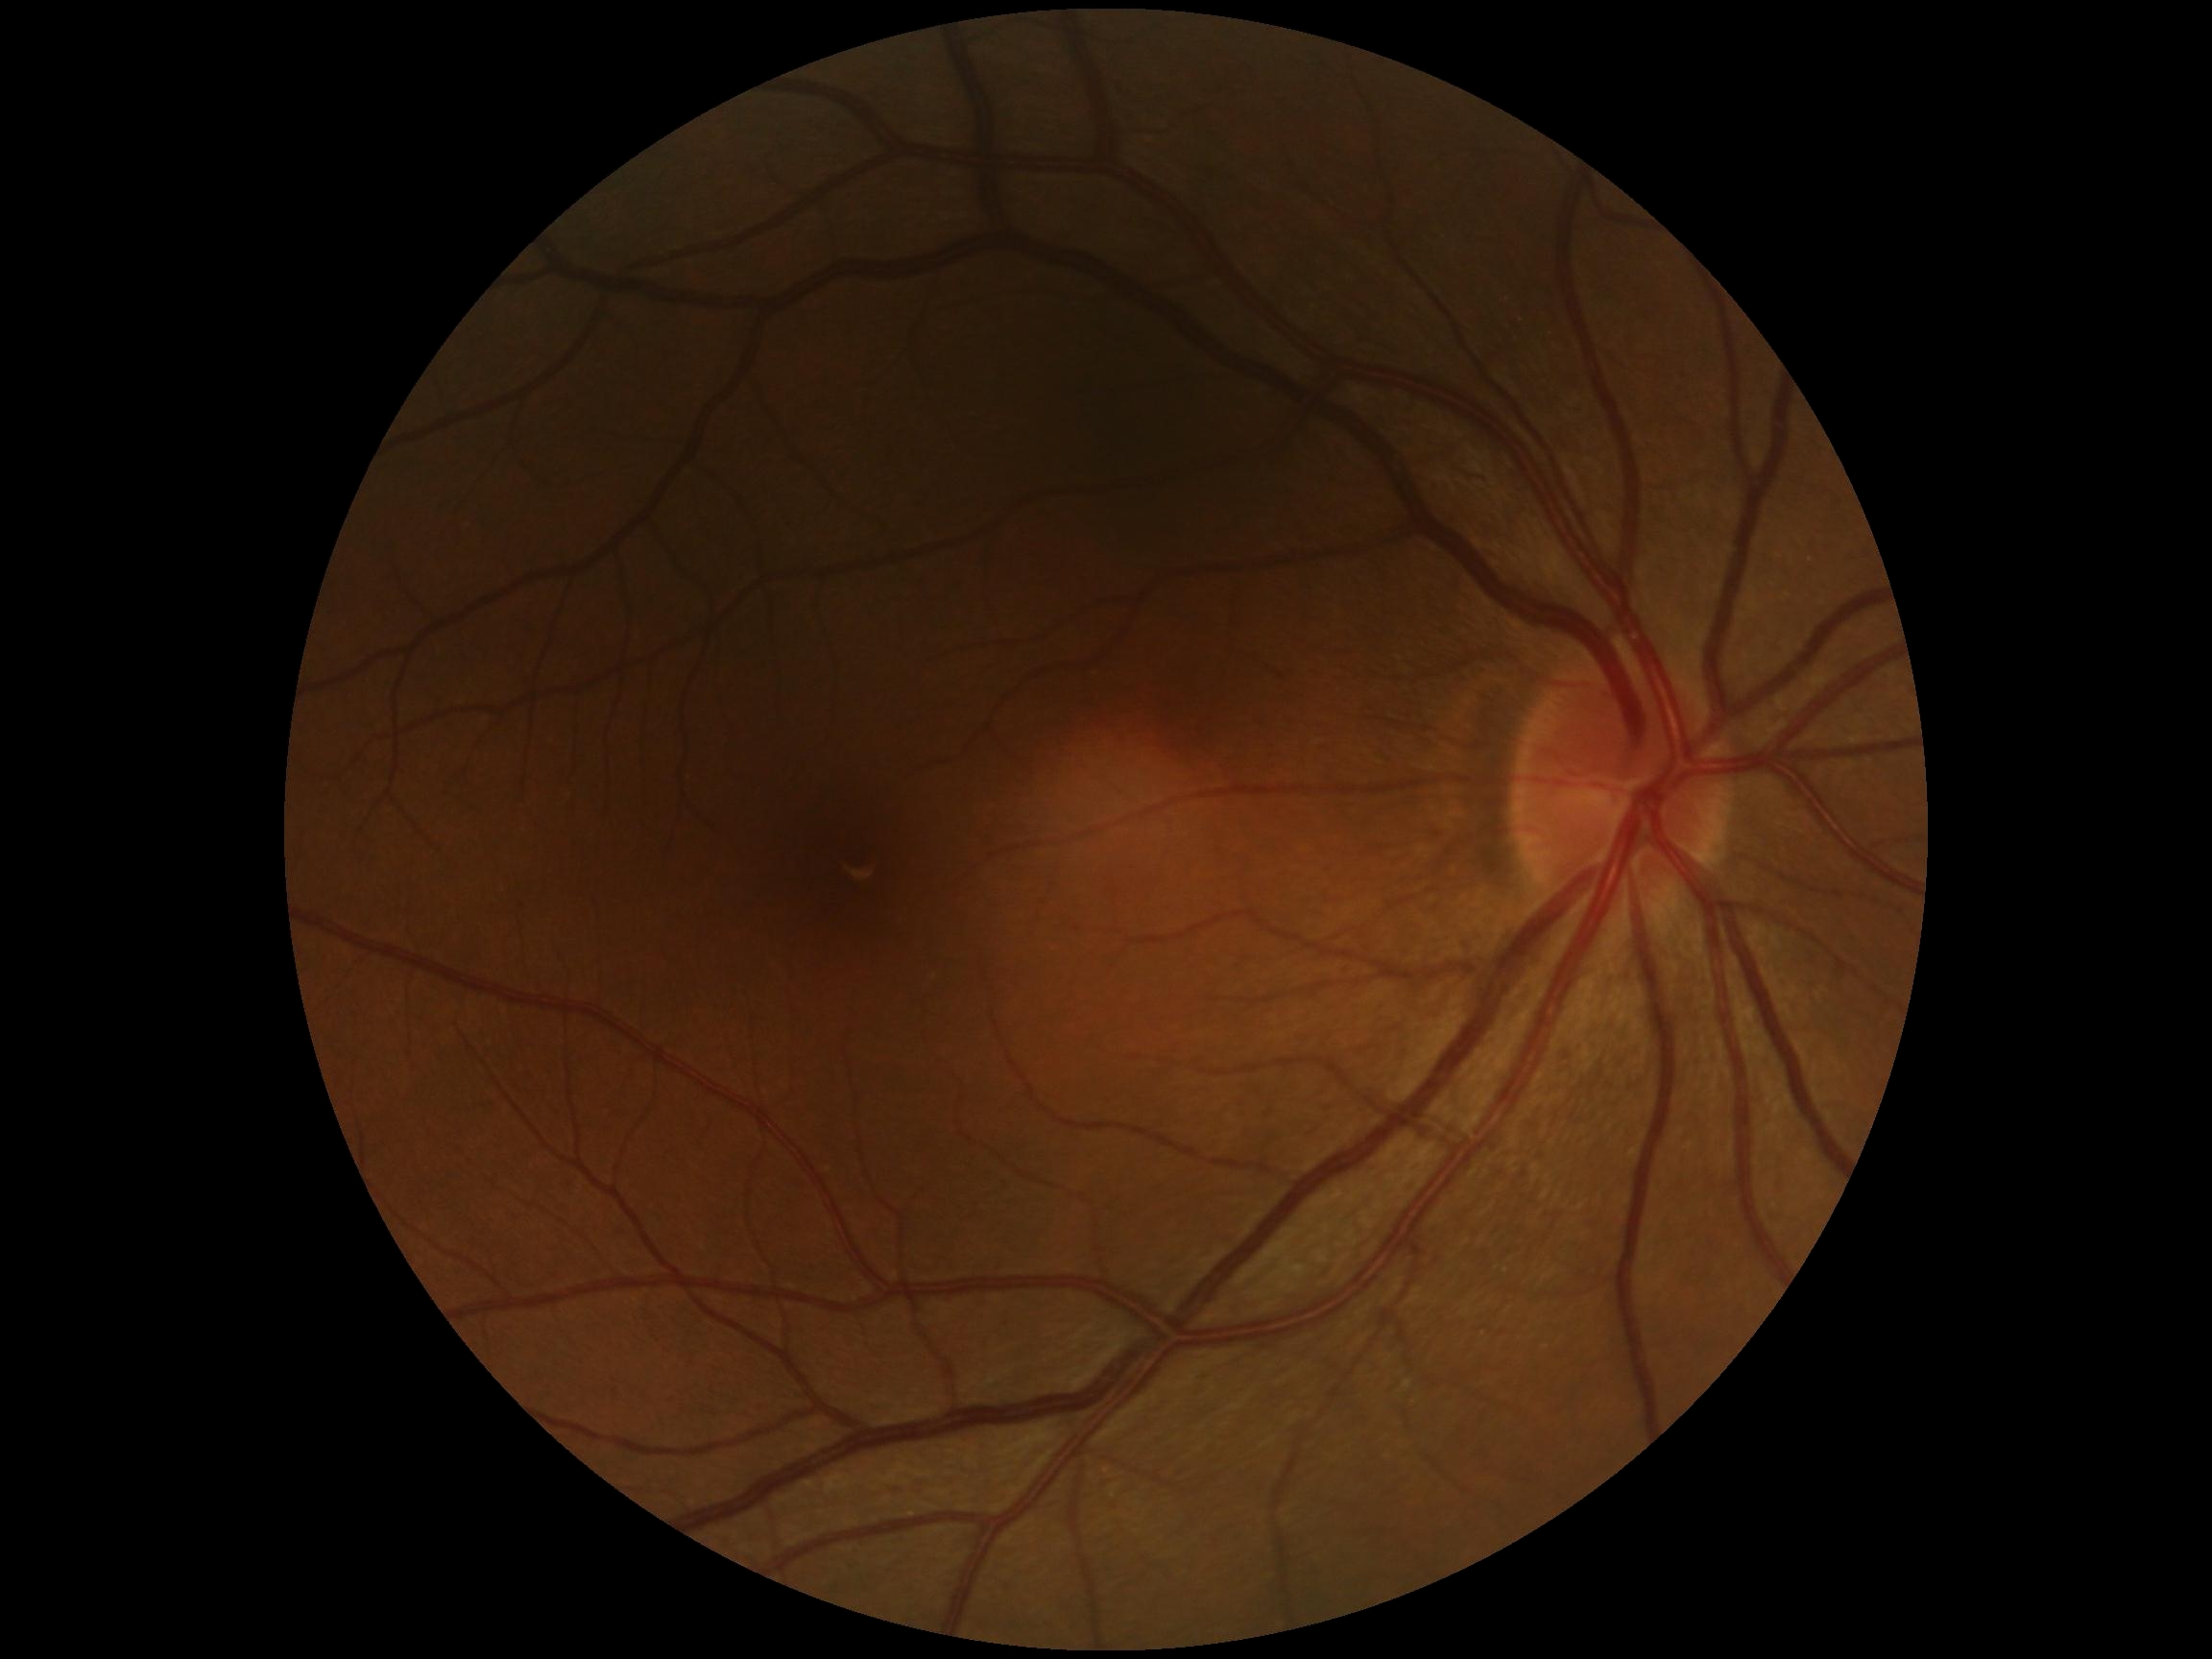

Diabetic retinopathy (DR): no apparent diabetic retinopathy (grade 0). No apparent diabetic retinopathy.